200° field of view · 1924 x 1556 pixels: 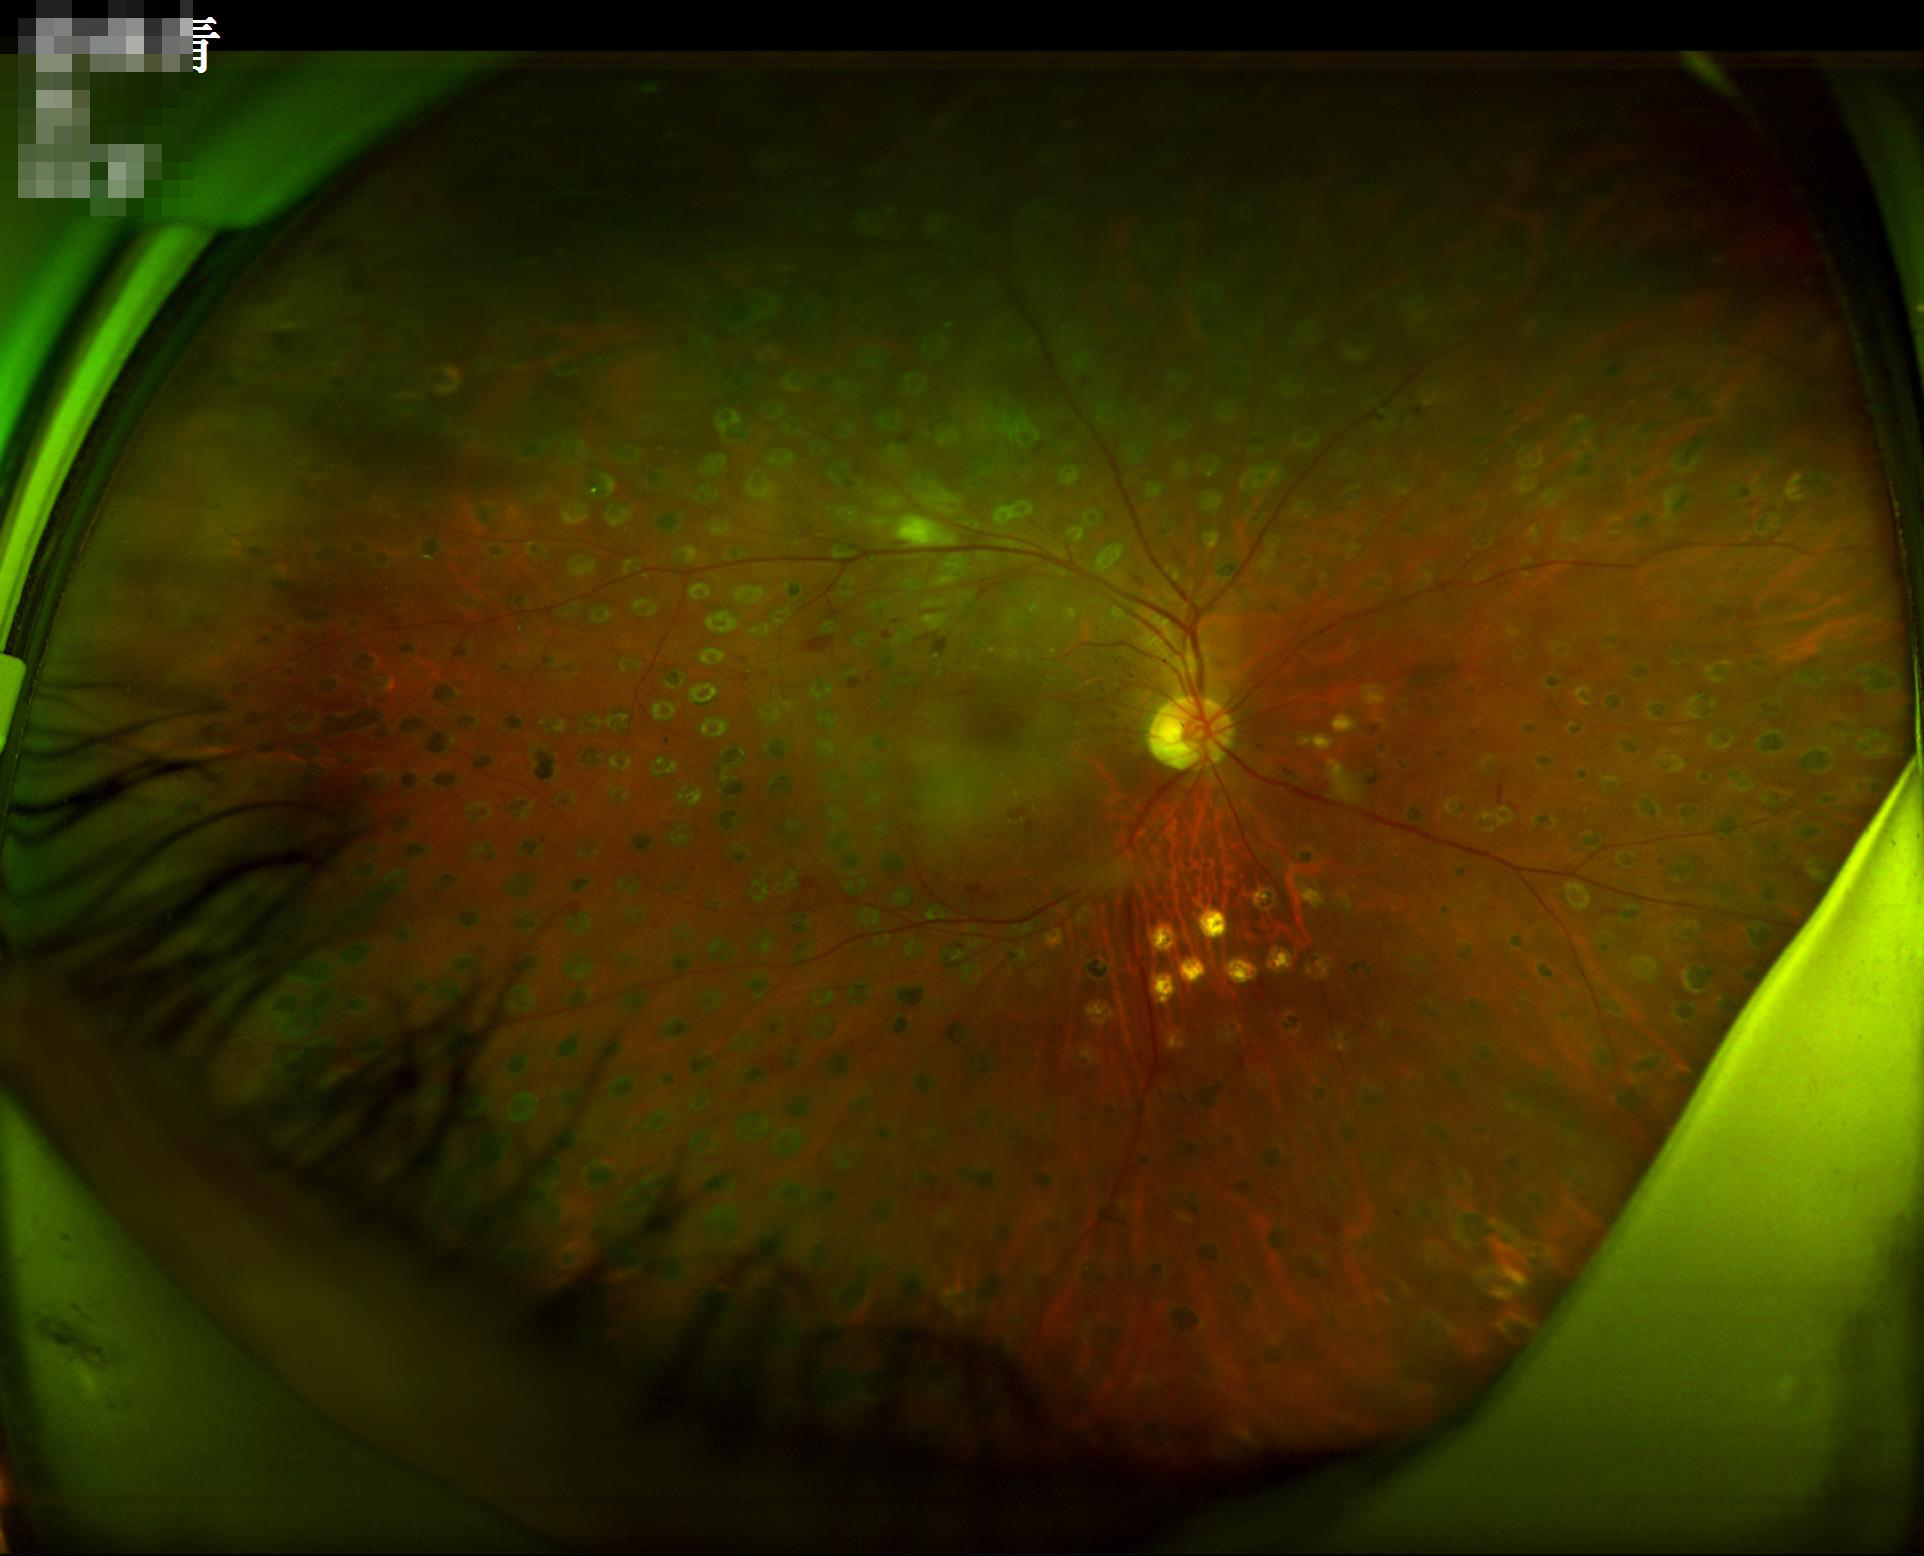 Overall image quality = adequate; Illumination = suboptimal.